NIDEK AFC-230 fundus camera: 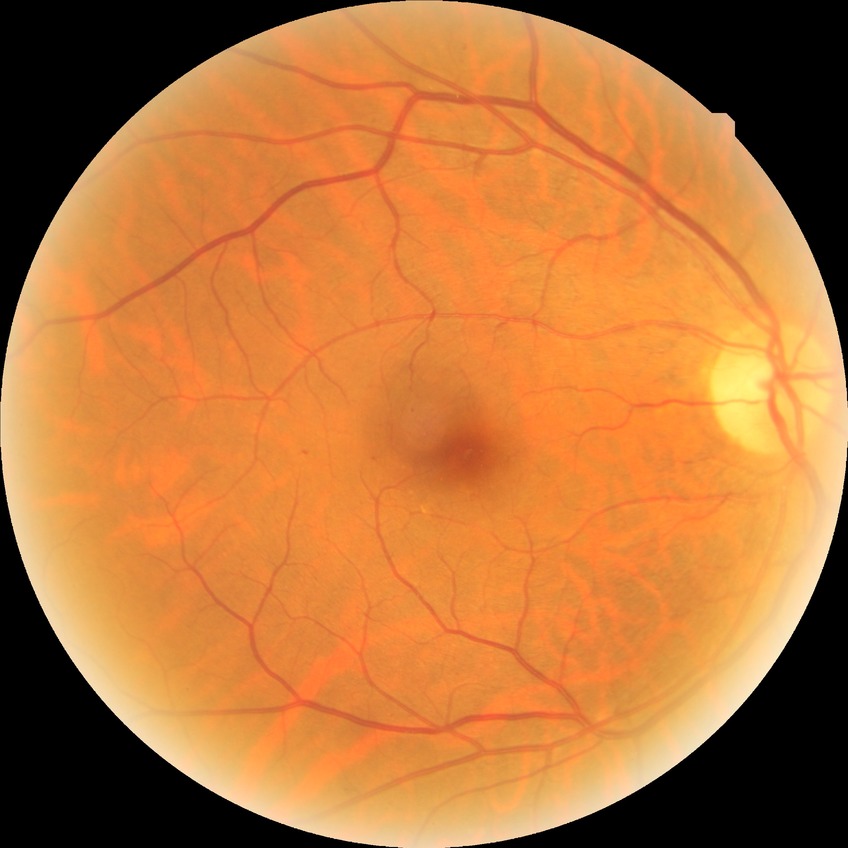

diabetic retinopathy (DR): SDR (simple diabetic retinopathy)